45-degree field of view: 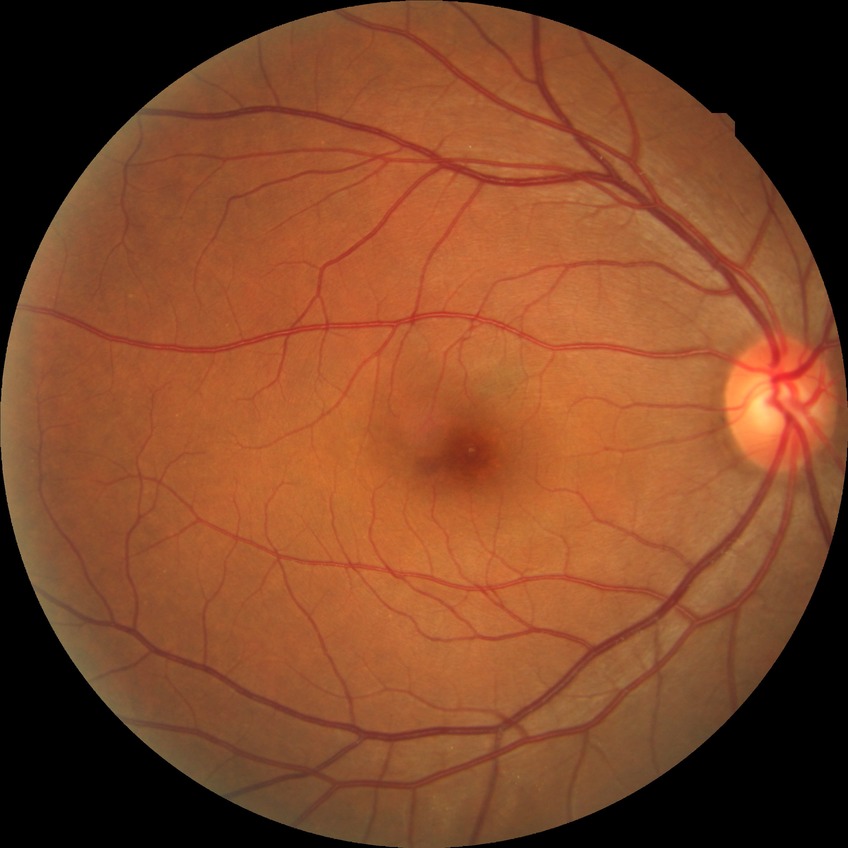

{
  "dr_impression": "no apparent DR",
  "davis_grade": "NDR"
}